DR severity per modified Davis staging
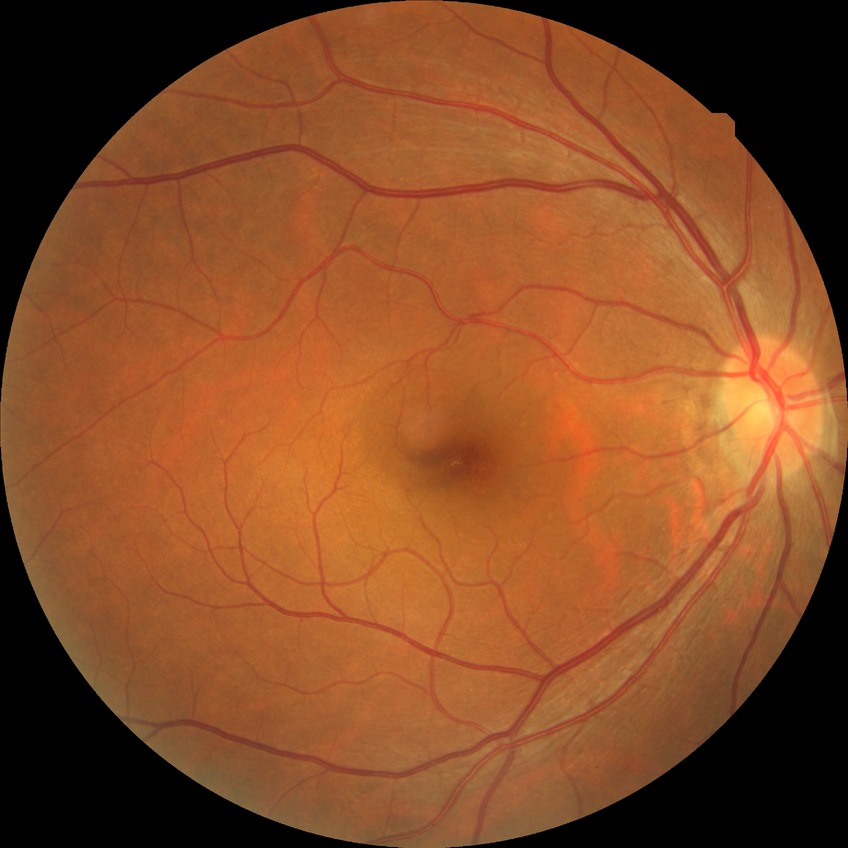
Diabetic retinopathy (DR) is no diabetic retinopathy (NDR).